Modified Davis classification, nonmydriatic
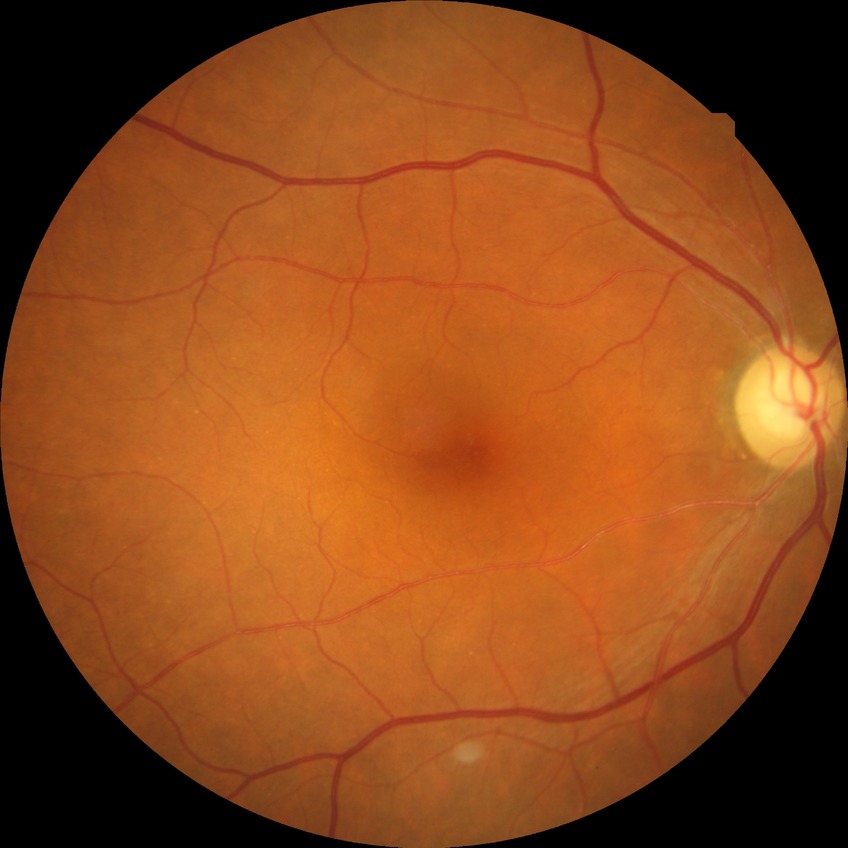
diabetic retinopathy (DR)=no diabetic retinopathy (NDR).